1932 by 1932 pixels, color fundus photograph
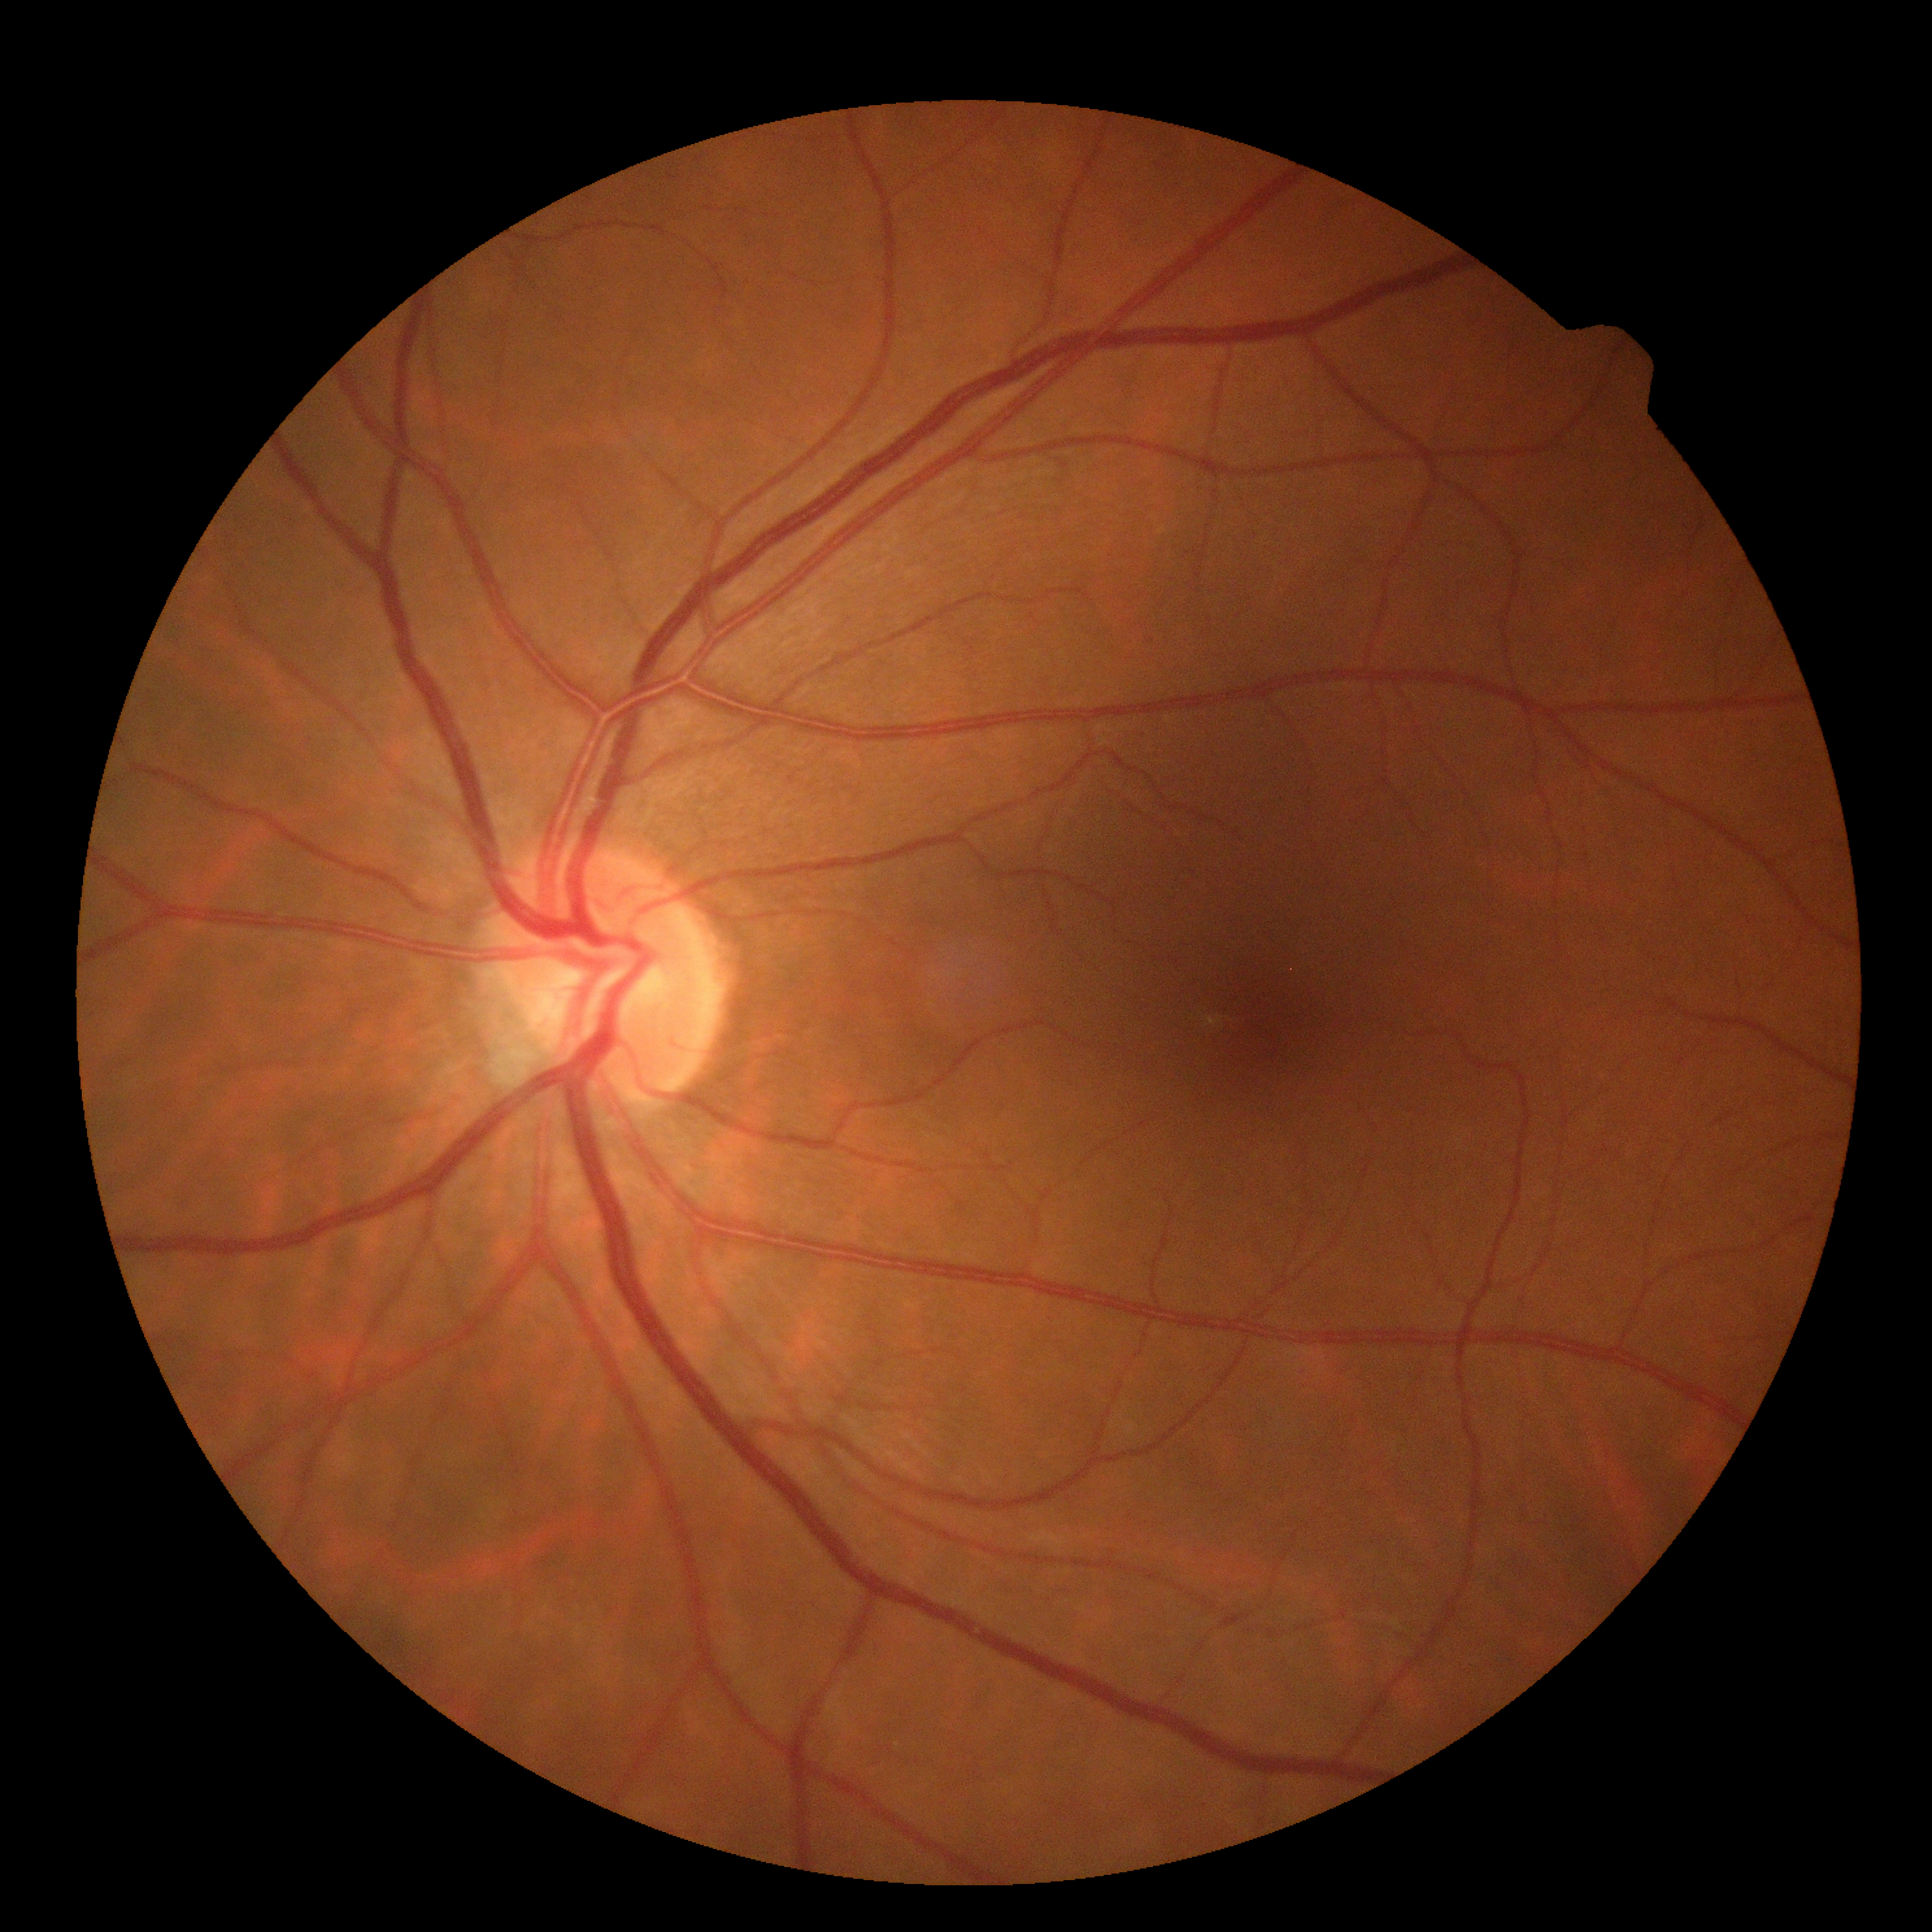
Diabetic retinopathy grade is 0 (no apparent retinopathy). No signs of diabetic retinopathy.